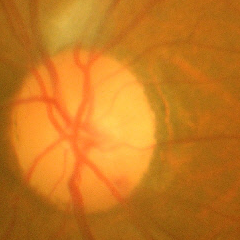
Q: What stage of glaucoma is present?
A: Yes — advanced glaucomatous optic neuropathy.